Without pupil dilation, retinal fundus photograph, 45 degree fundus photograph
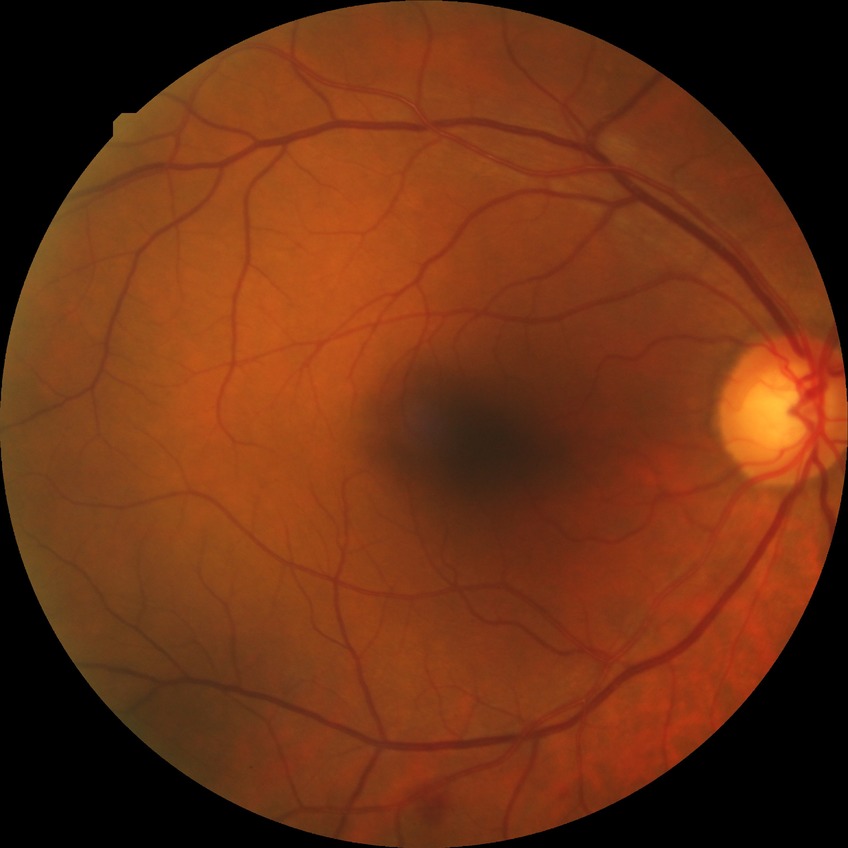
Retinopathy grade: simple diabetic retinopathy.